Posterior pole color fundus photograph.
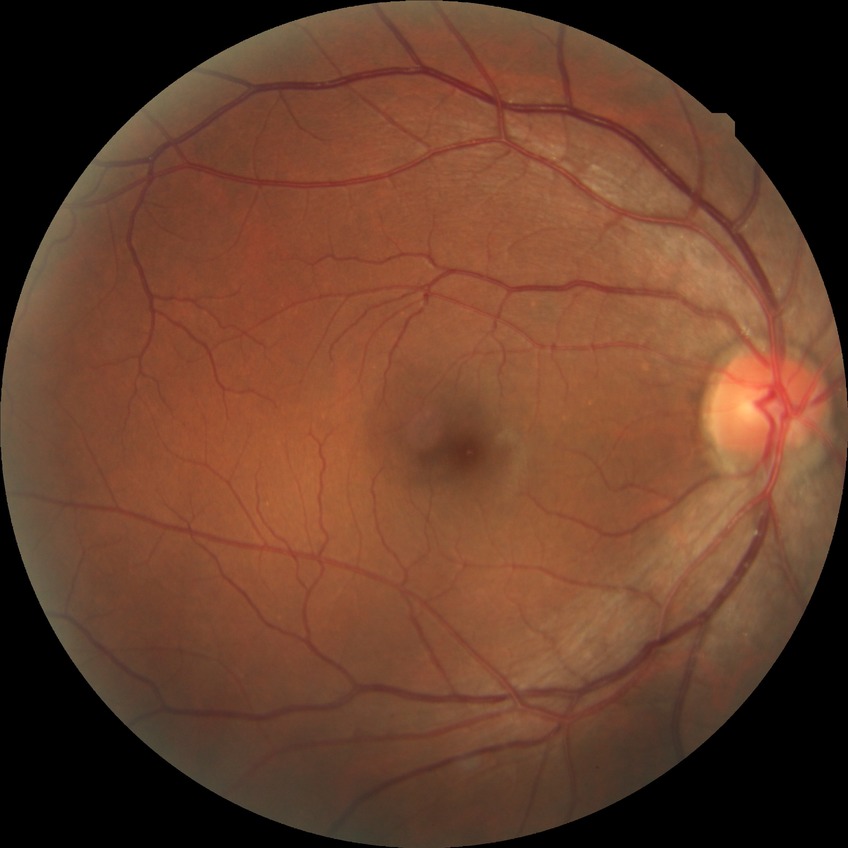
davis_grade: NDR (no diabetic retinopathy)